Fundus photo.
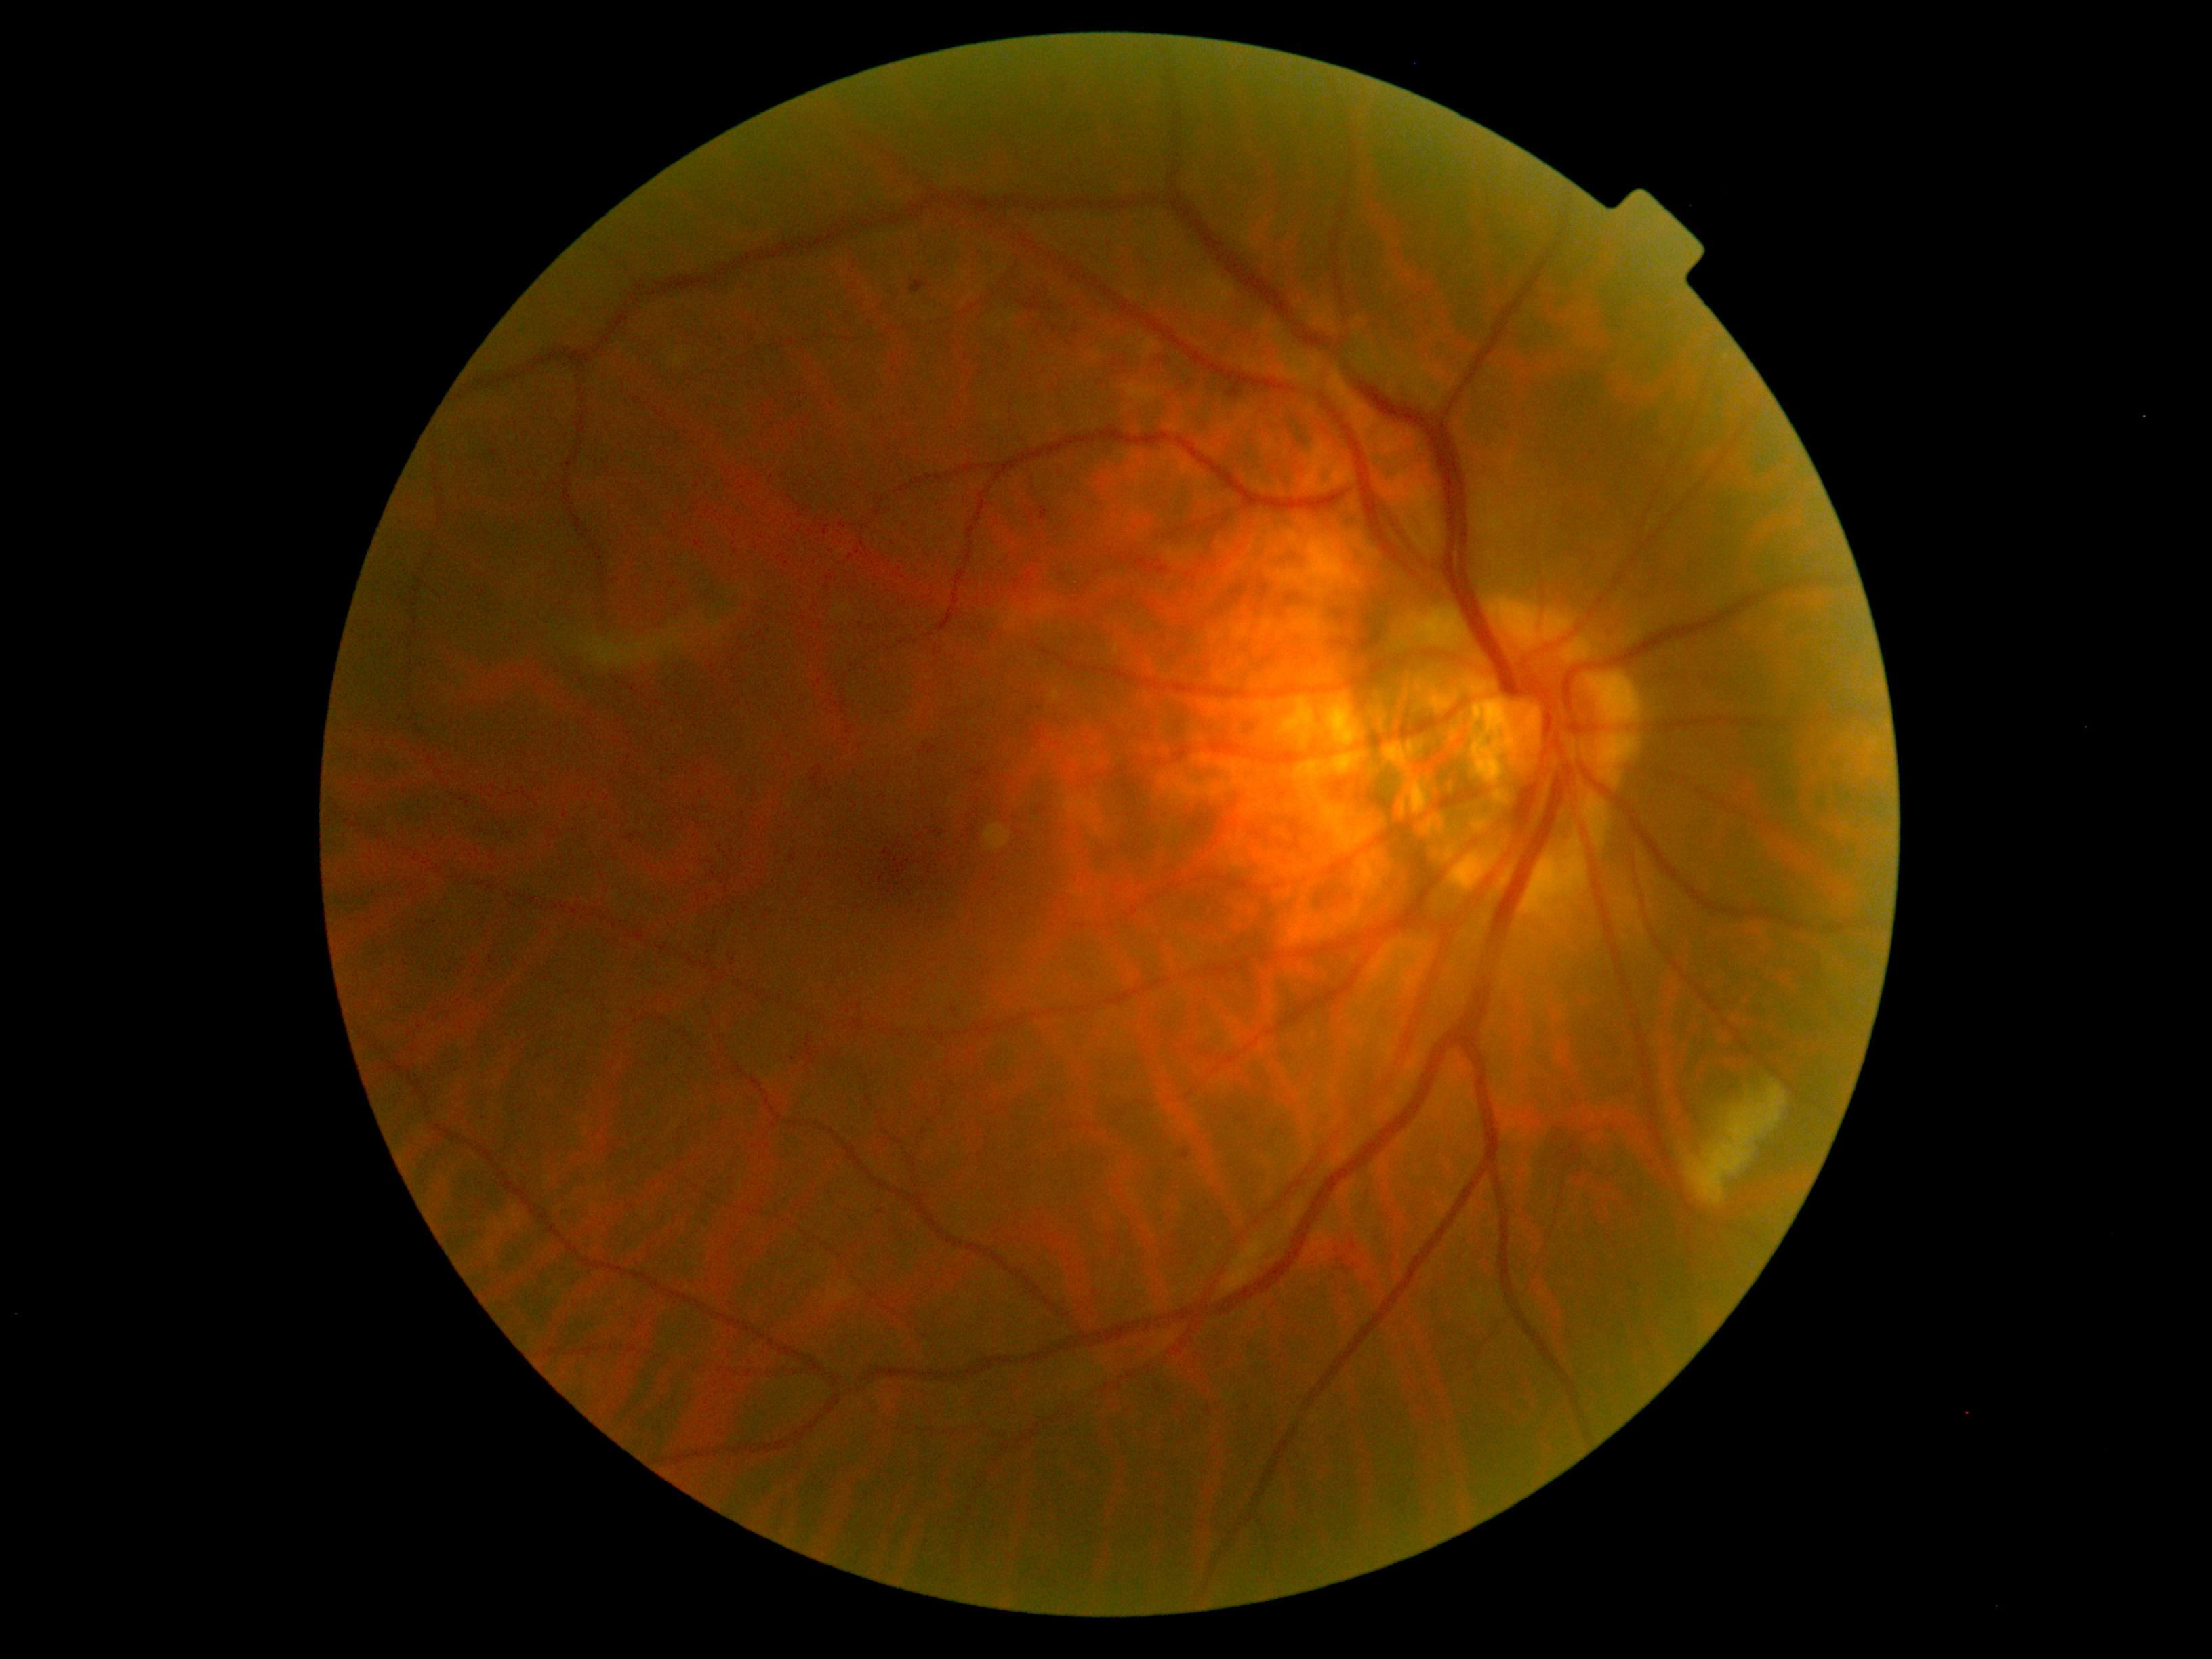 DR stage: grade 2 (moderate NPDR).